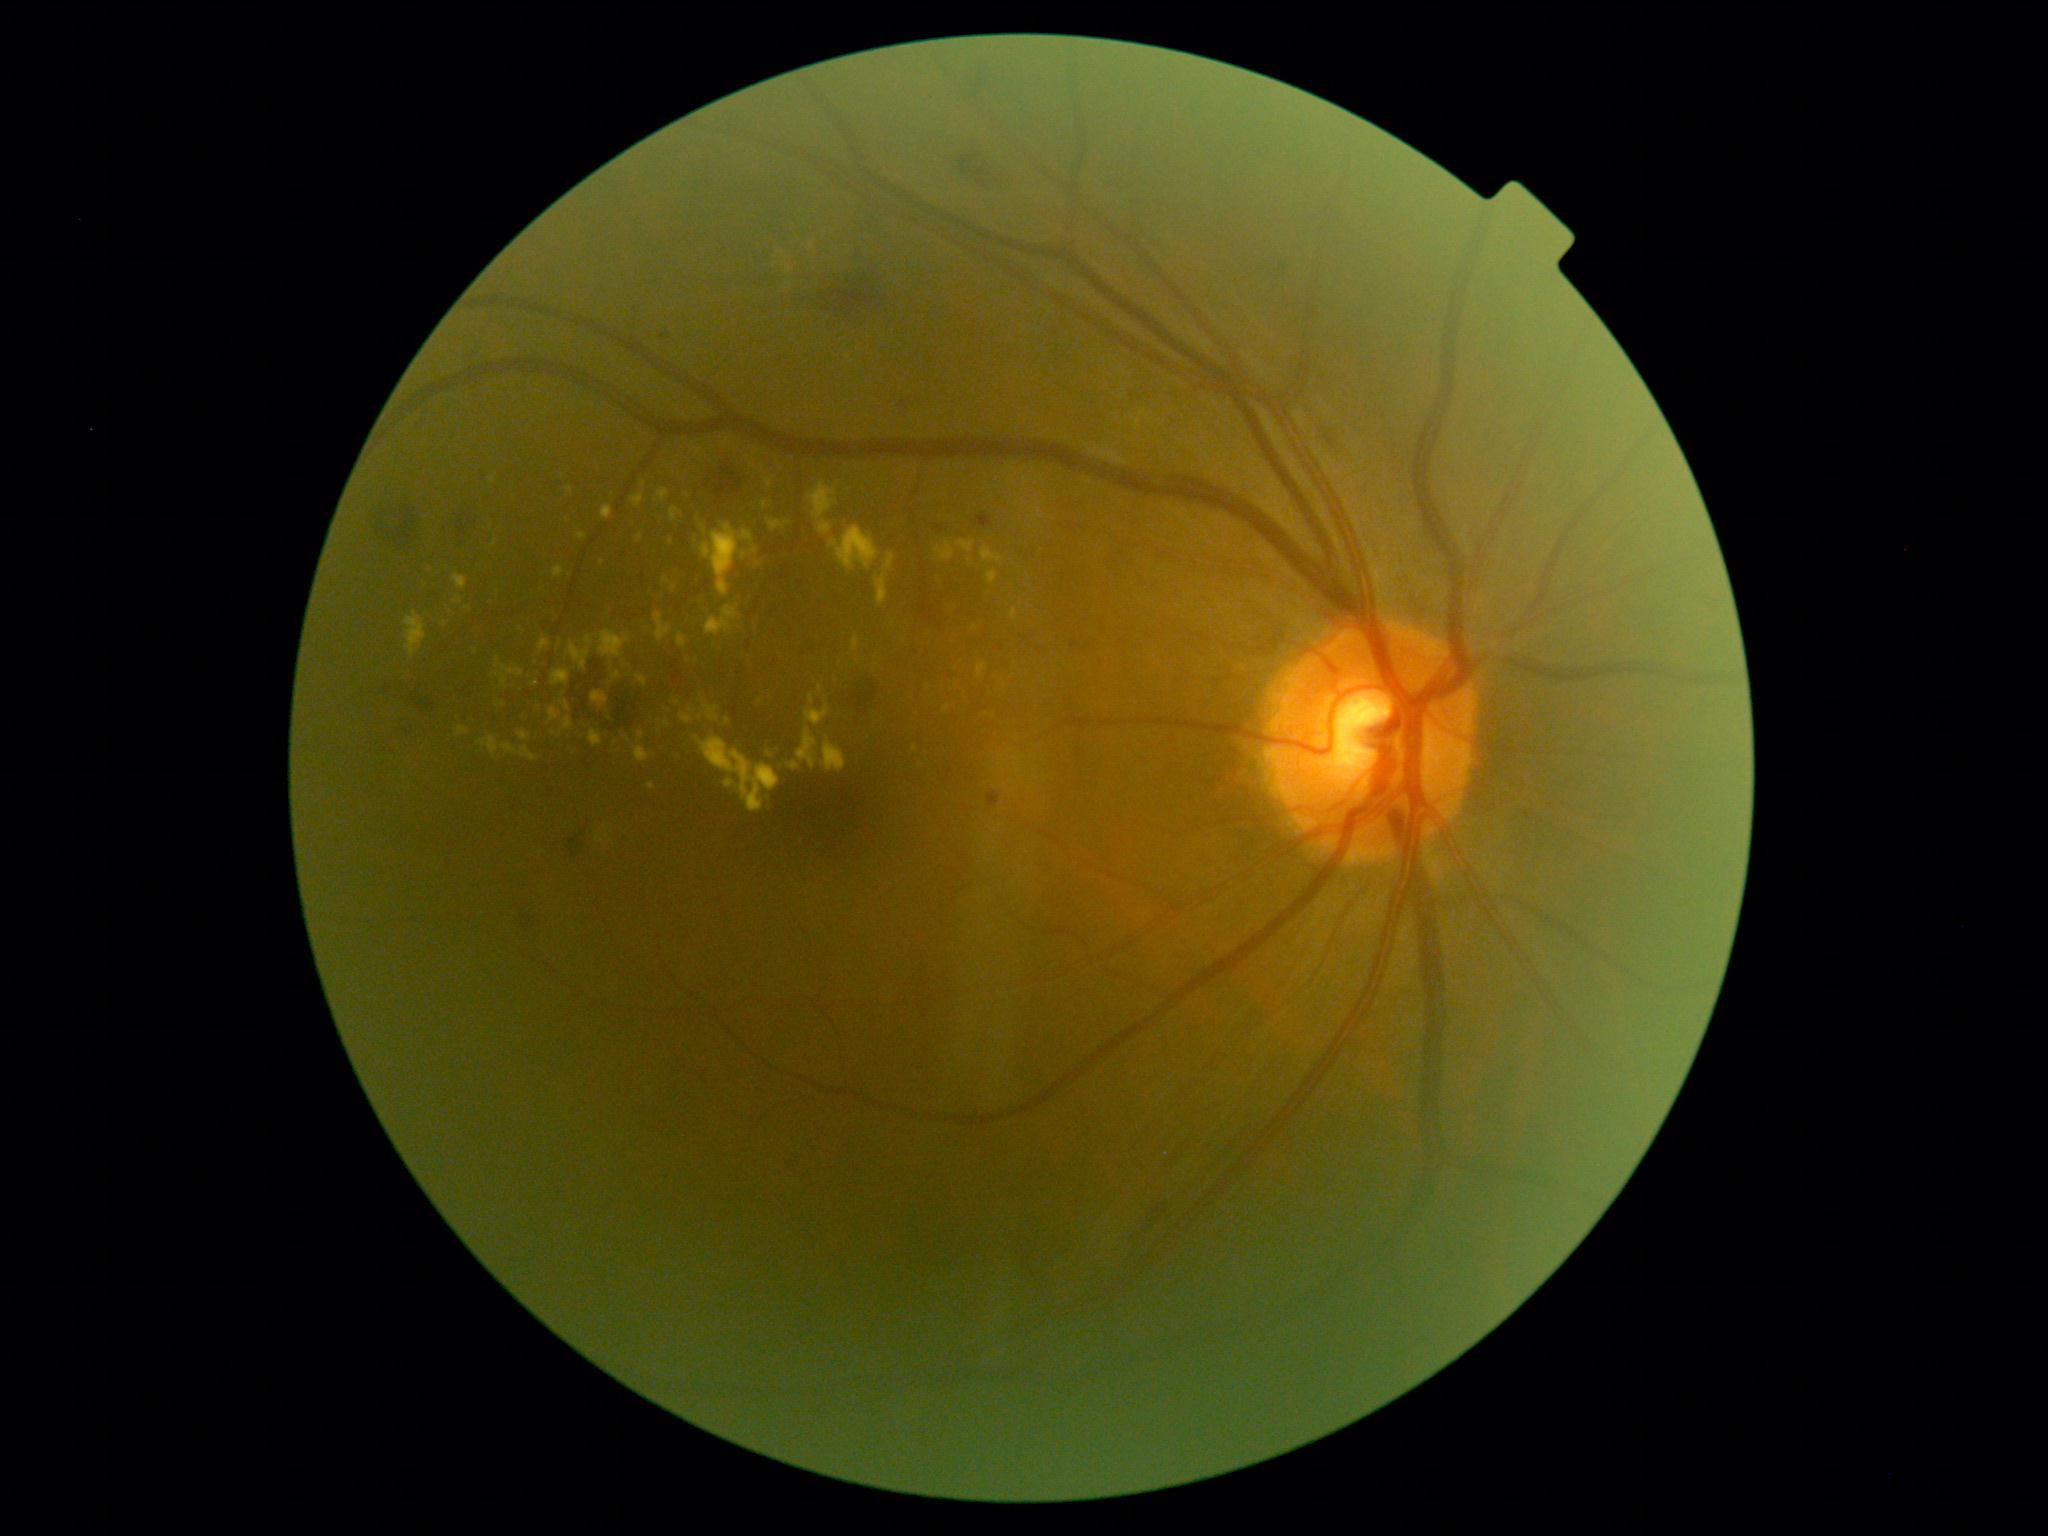
Diabetic retinopathy (DR): 2
Representative lesions:
hard exudates (EXs) (partial): bbox=[681, 713, 694, 724], bbox=[635, 747, 651, 763], bbox=[797, 729, 818, 769], bbox=[636, 674, 648, 687], bbox=[481, 736, 498, 759], bbox=[818, 521, 833, 535], bbox=[808, 483, 838, 521], bbox=[762, 502, 770, 509], bbox=[638, 731, 645, 740], bbox=[788, 762, 801, 772]
Small EXs near point(752, 467), point(494, 544), point(986, 714), point(1040, 511), point(975, 629), point(640, 538), point(469, 609)